Diabetic retinopathy graded by the modified Davis classification · NIDEK AFC-230:
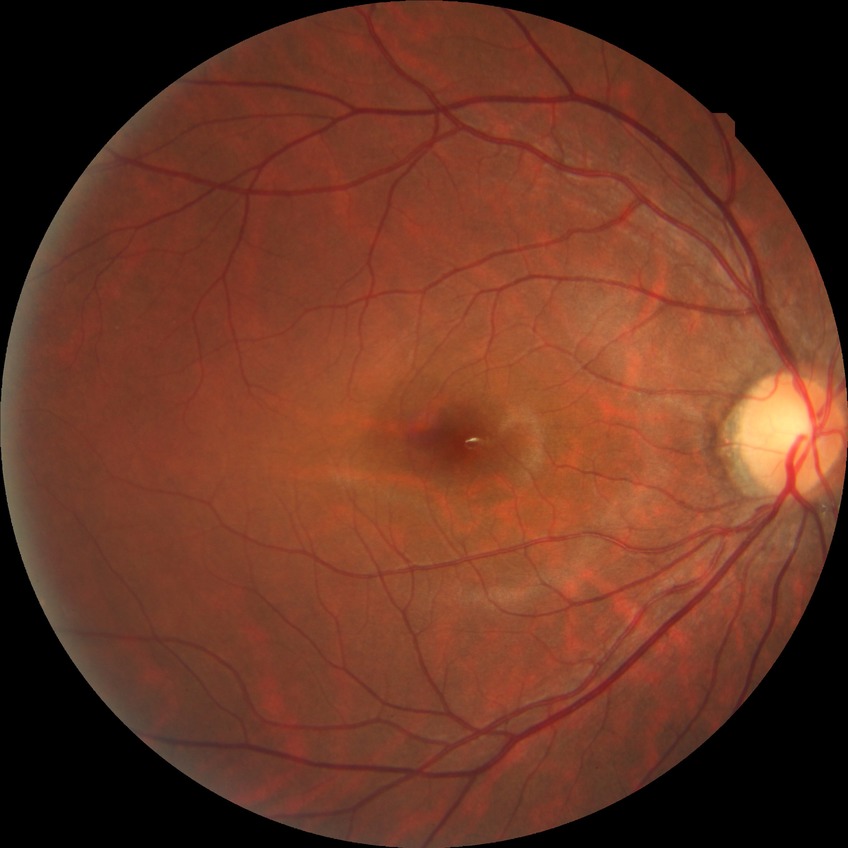
Davis grading is no diabetic retinopathy.